Remidio FOP fundus camera
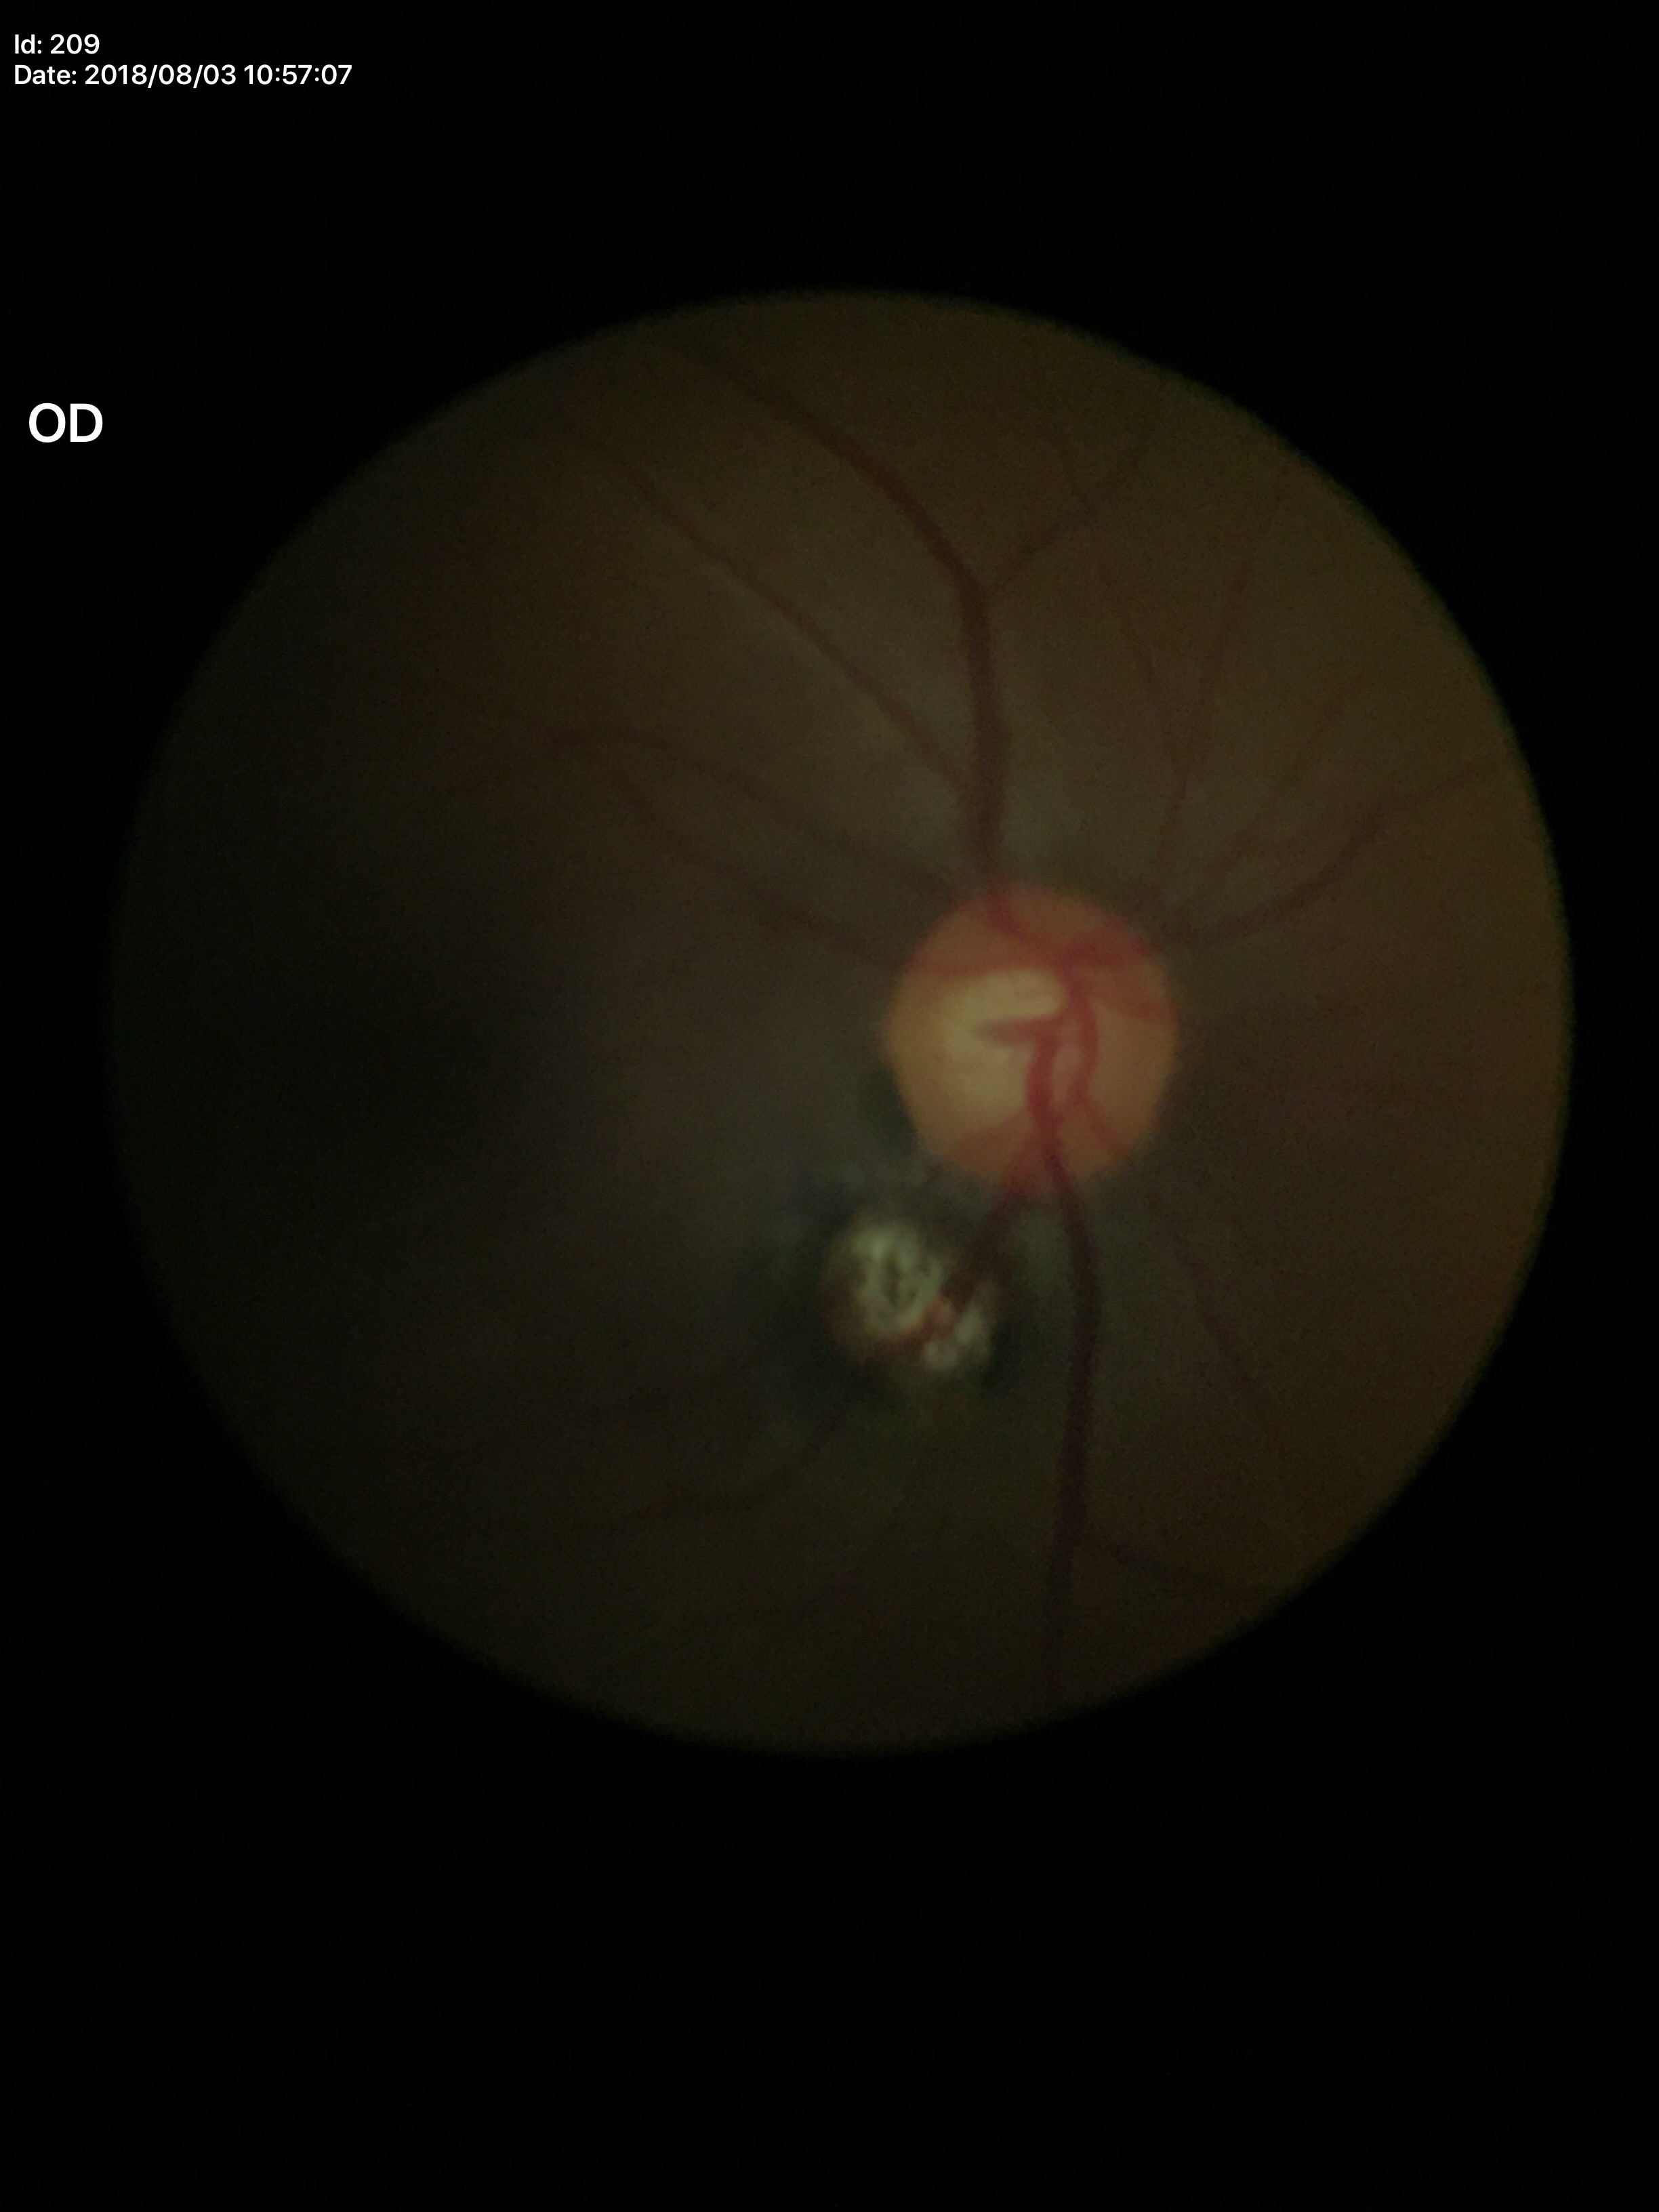

Glaucoma evaluation: not suspect | vertical cup-disc ratio (VCDR): 0.55.